Retinal fundus photograph: 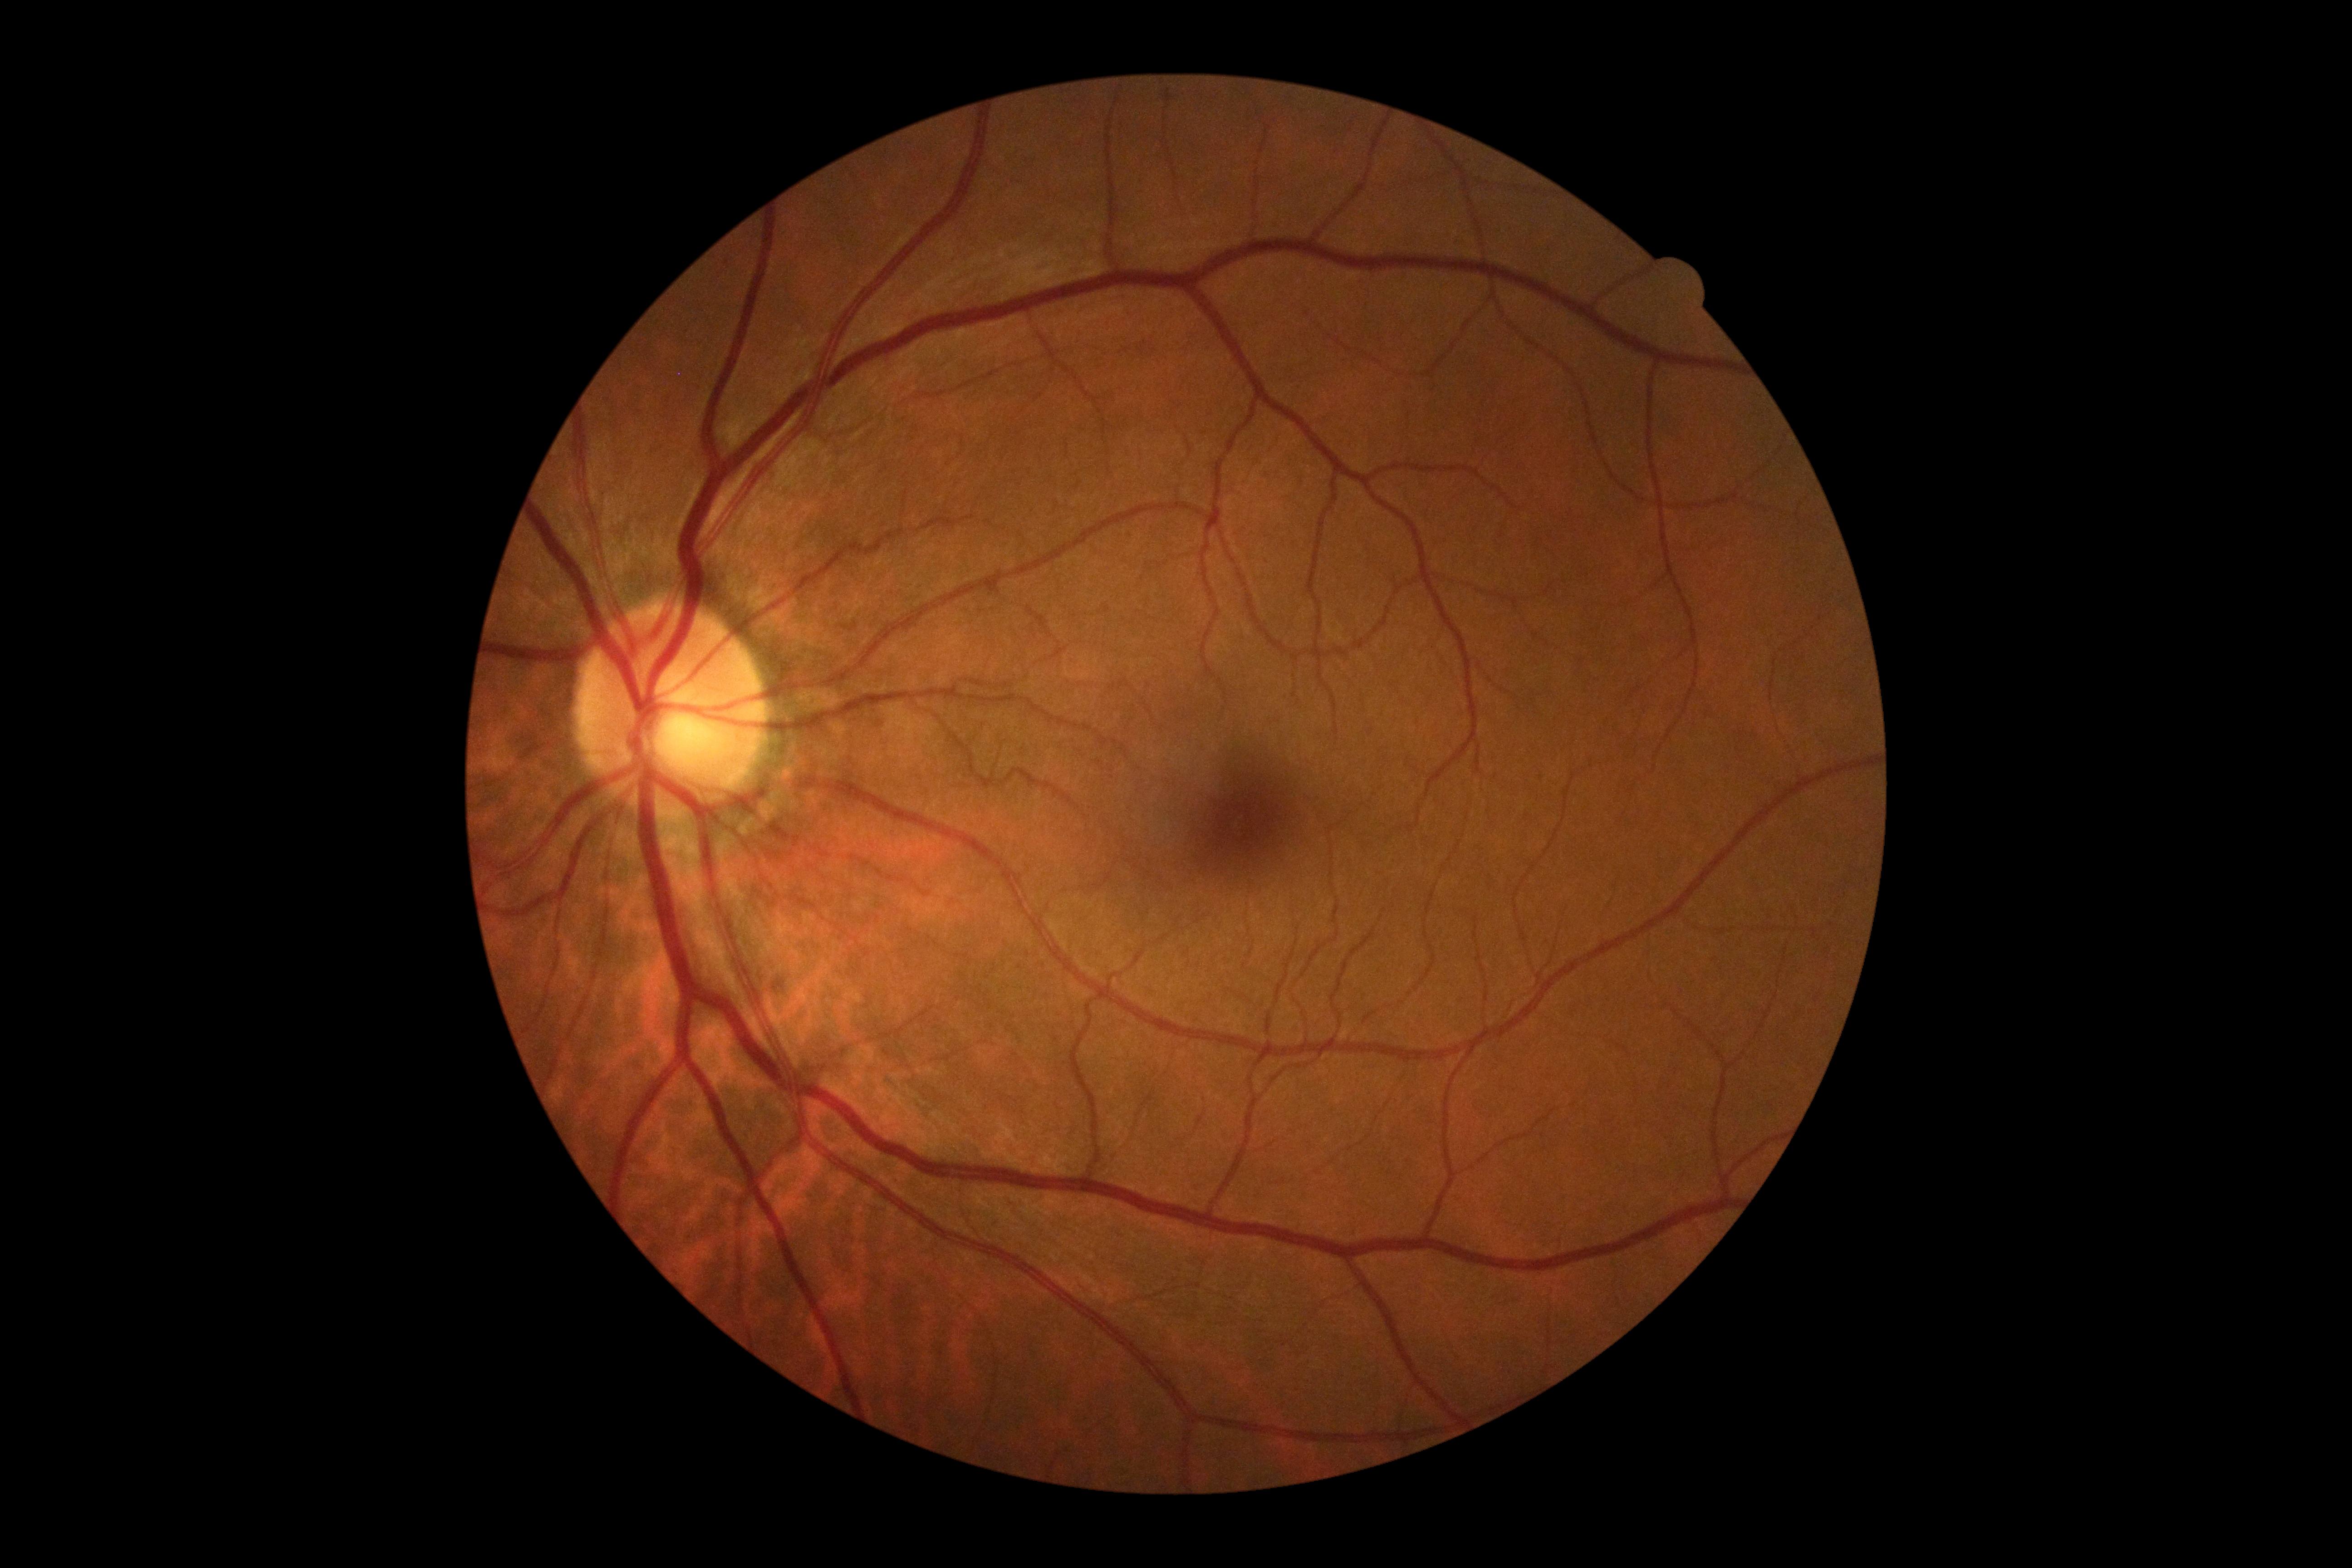
DR grade: 0/4.